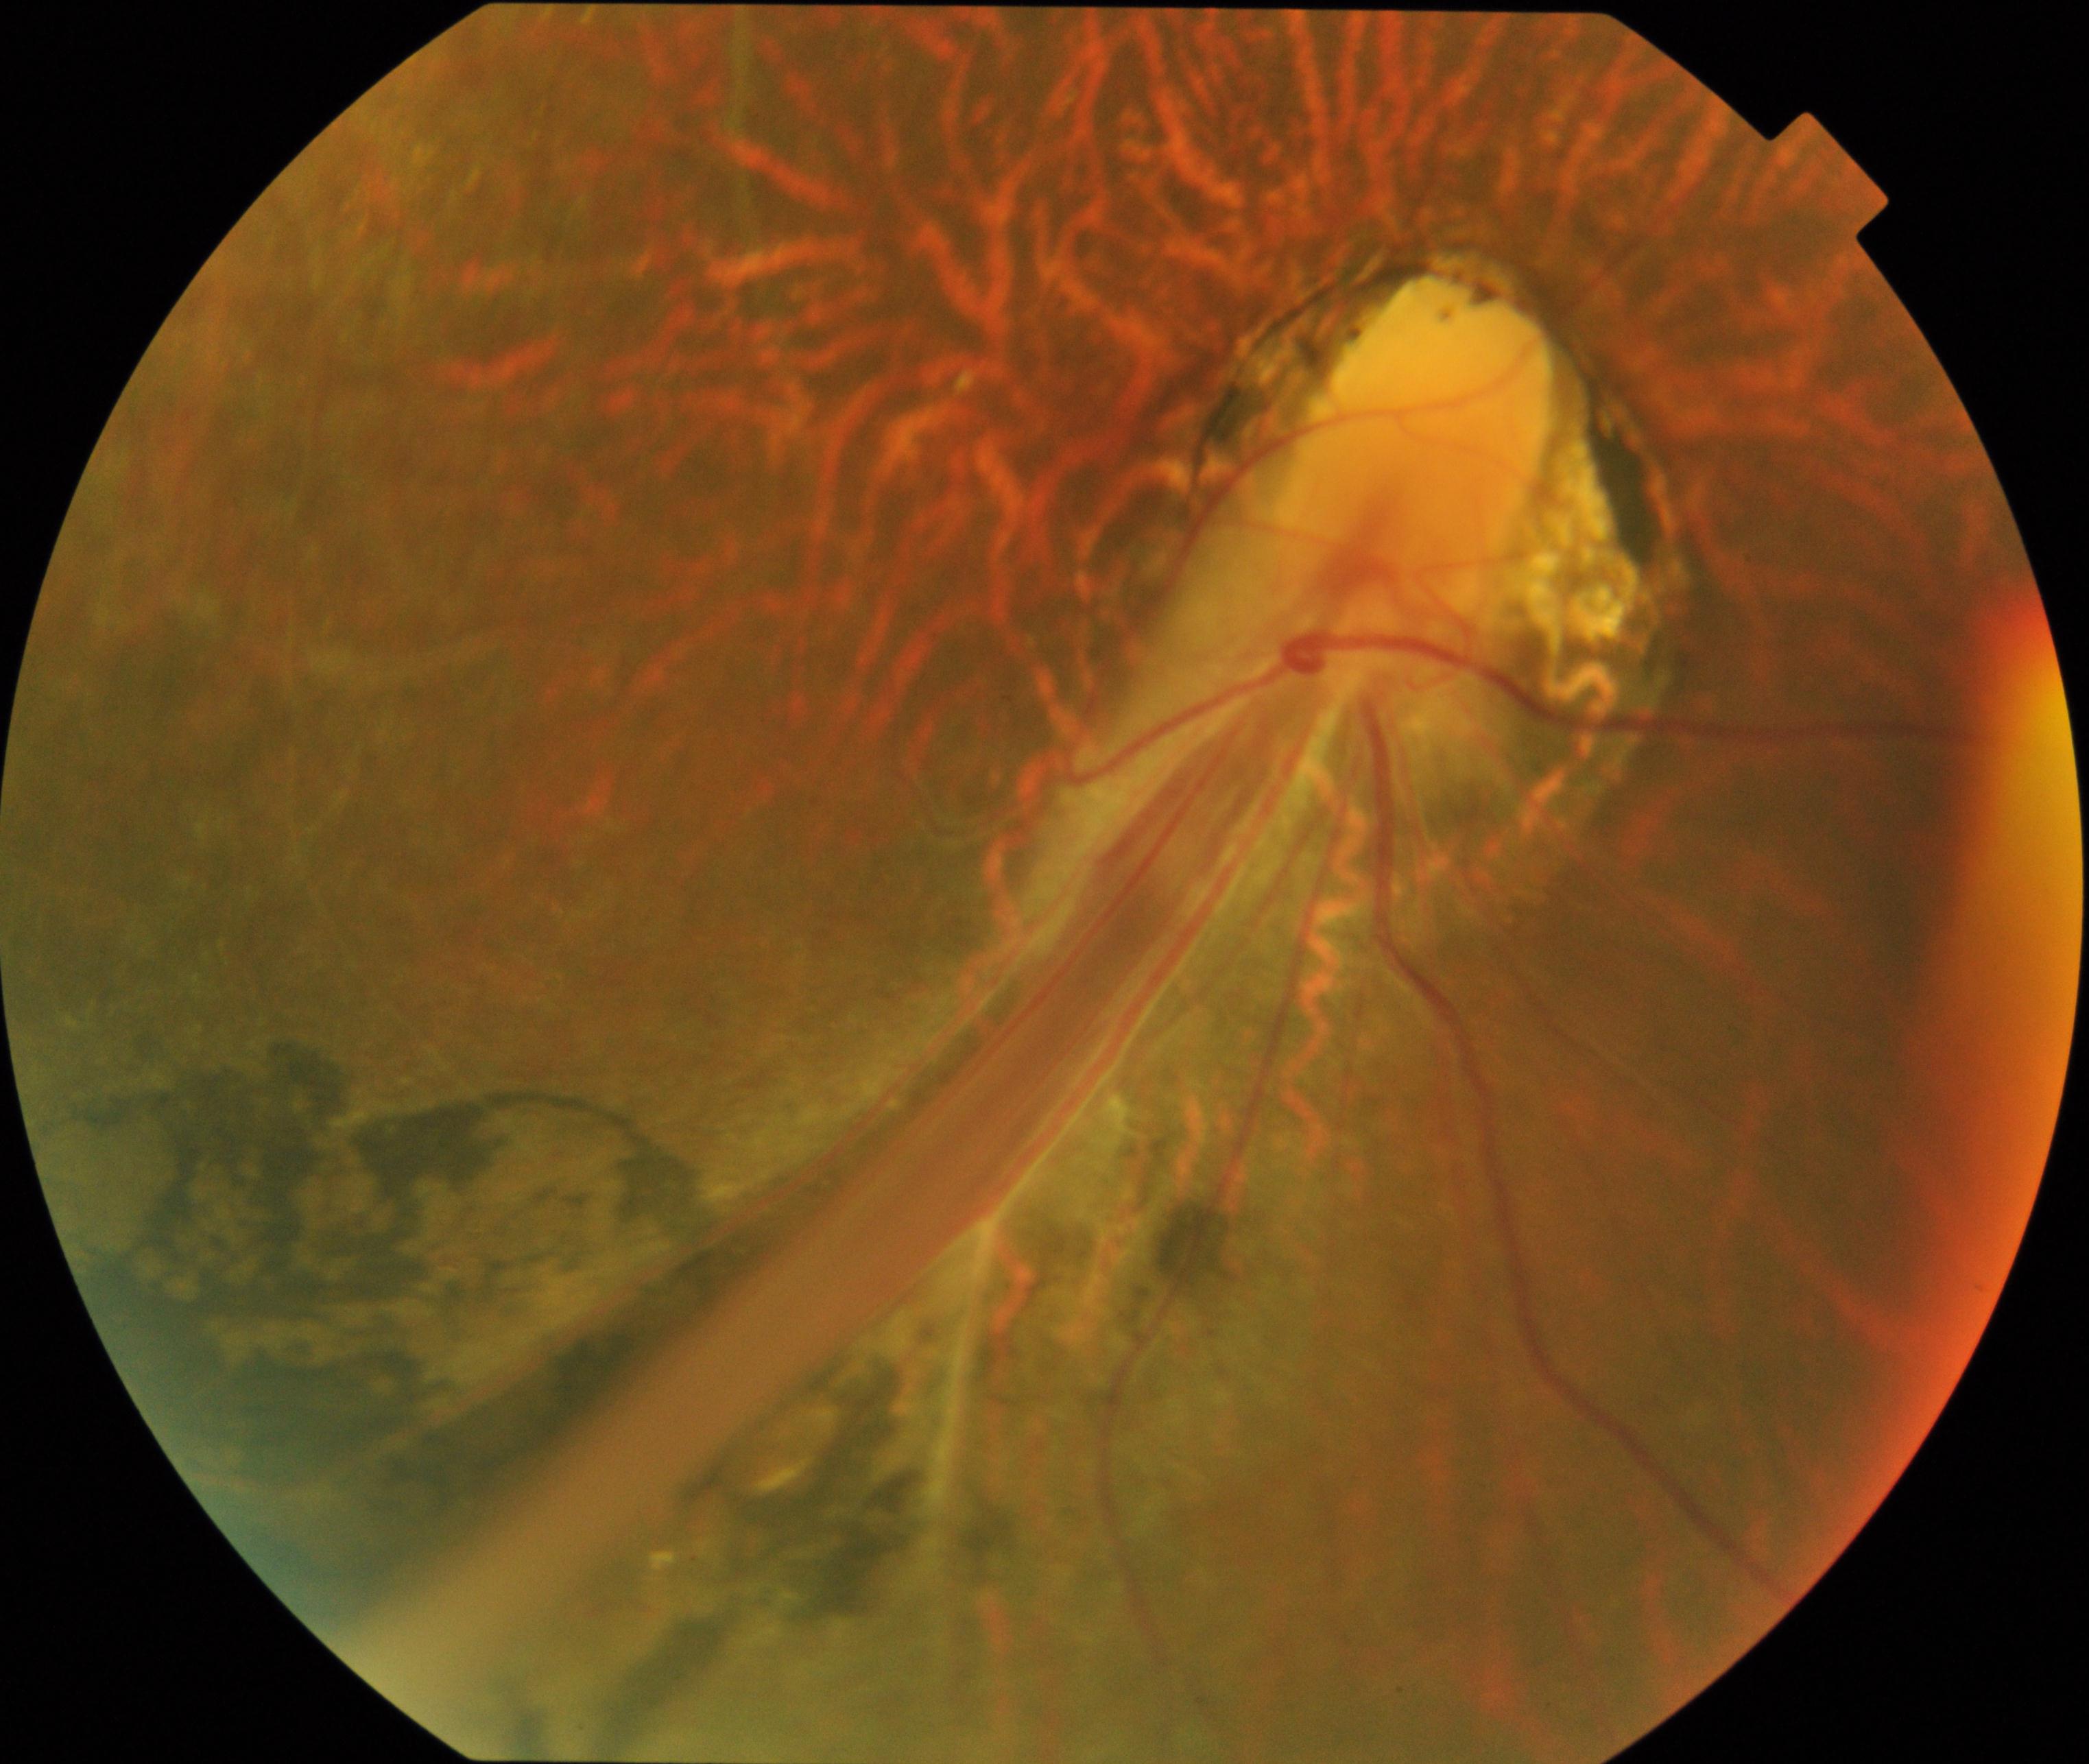

Primary finding: dragged disc.